Color fundus photograph; 1932x1932px; 45° field of view
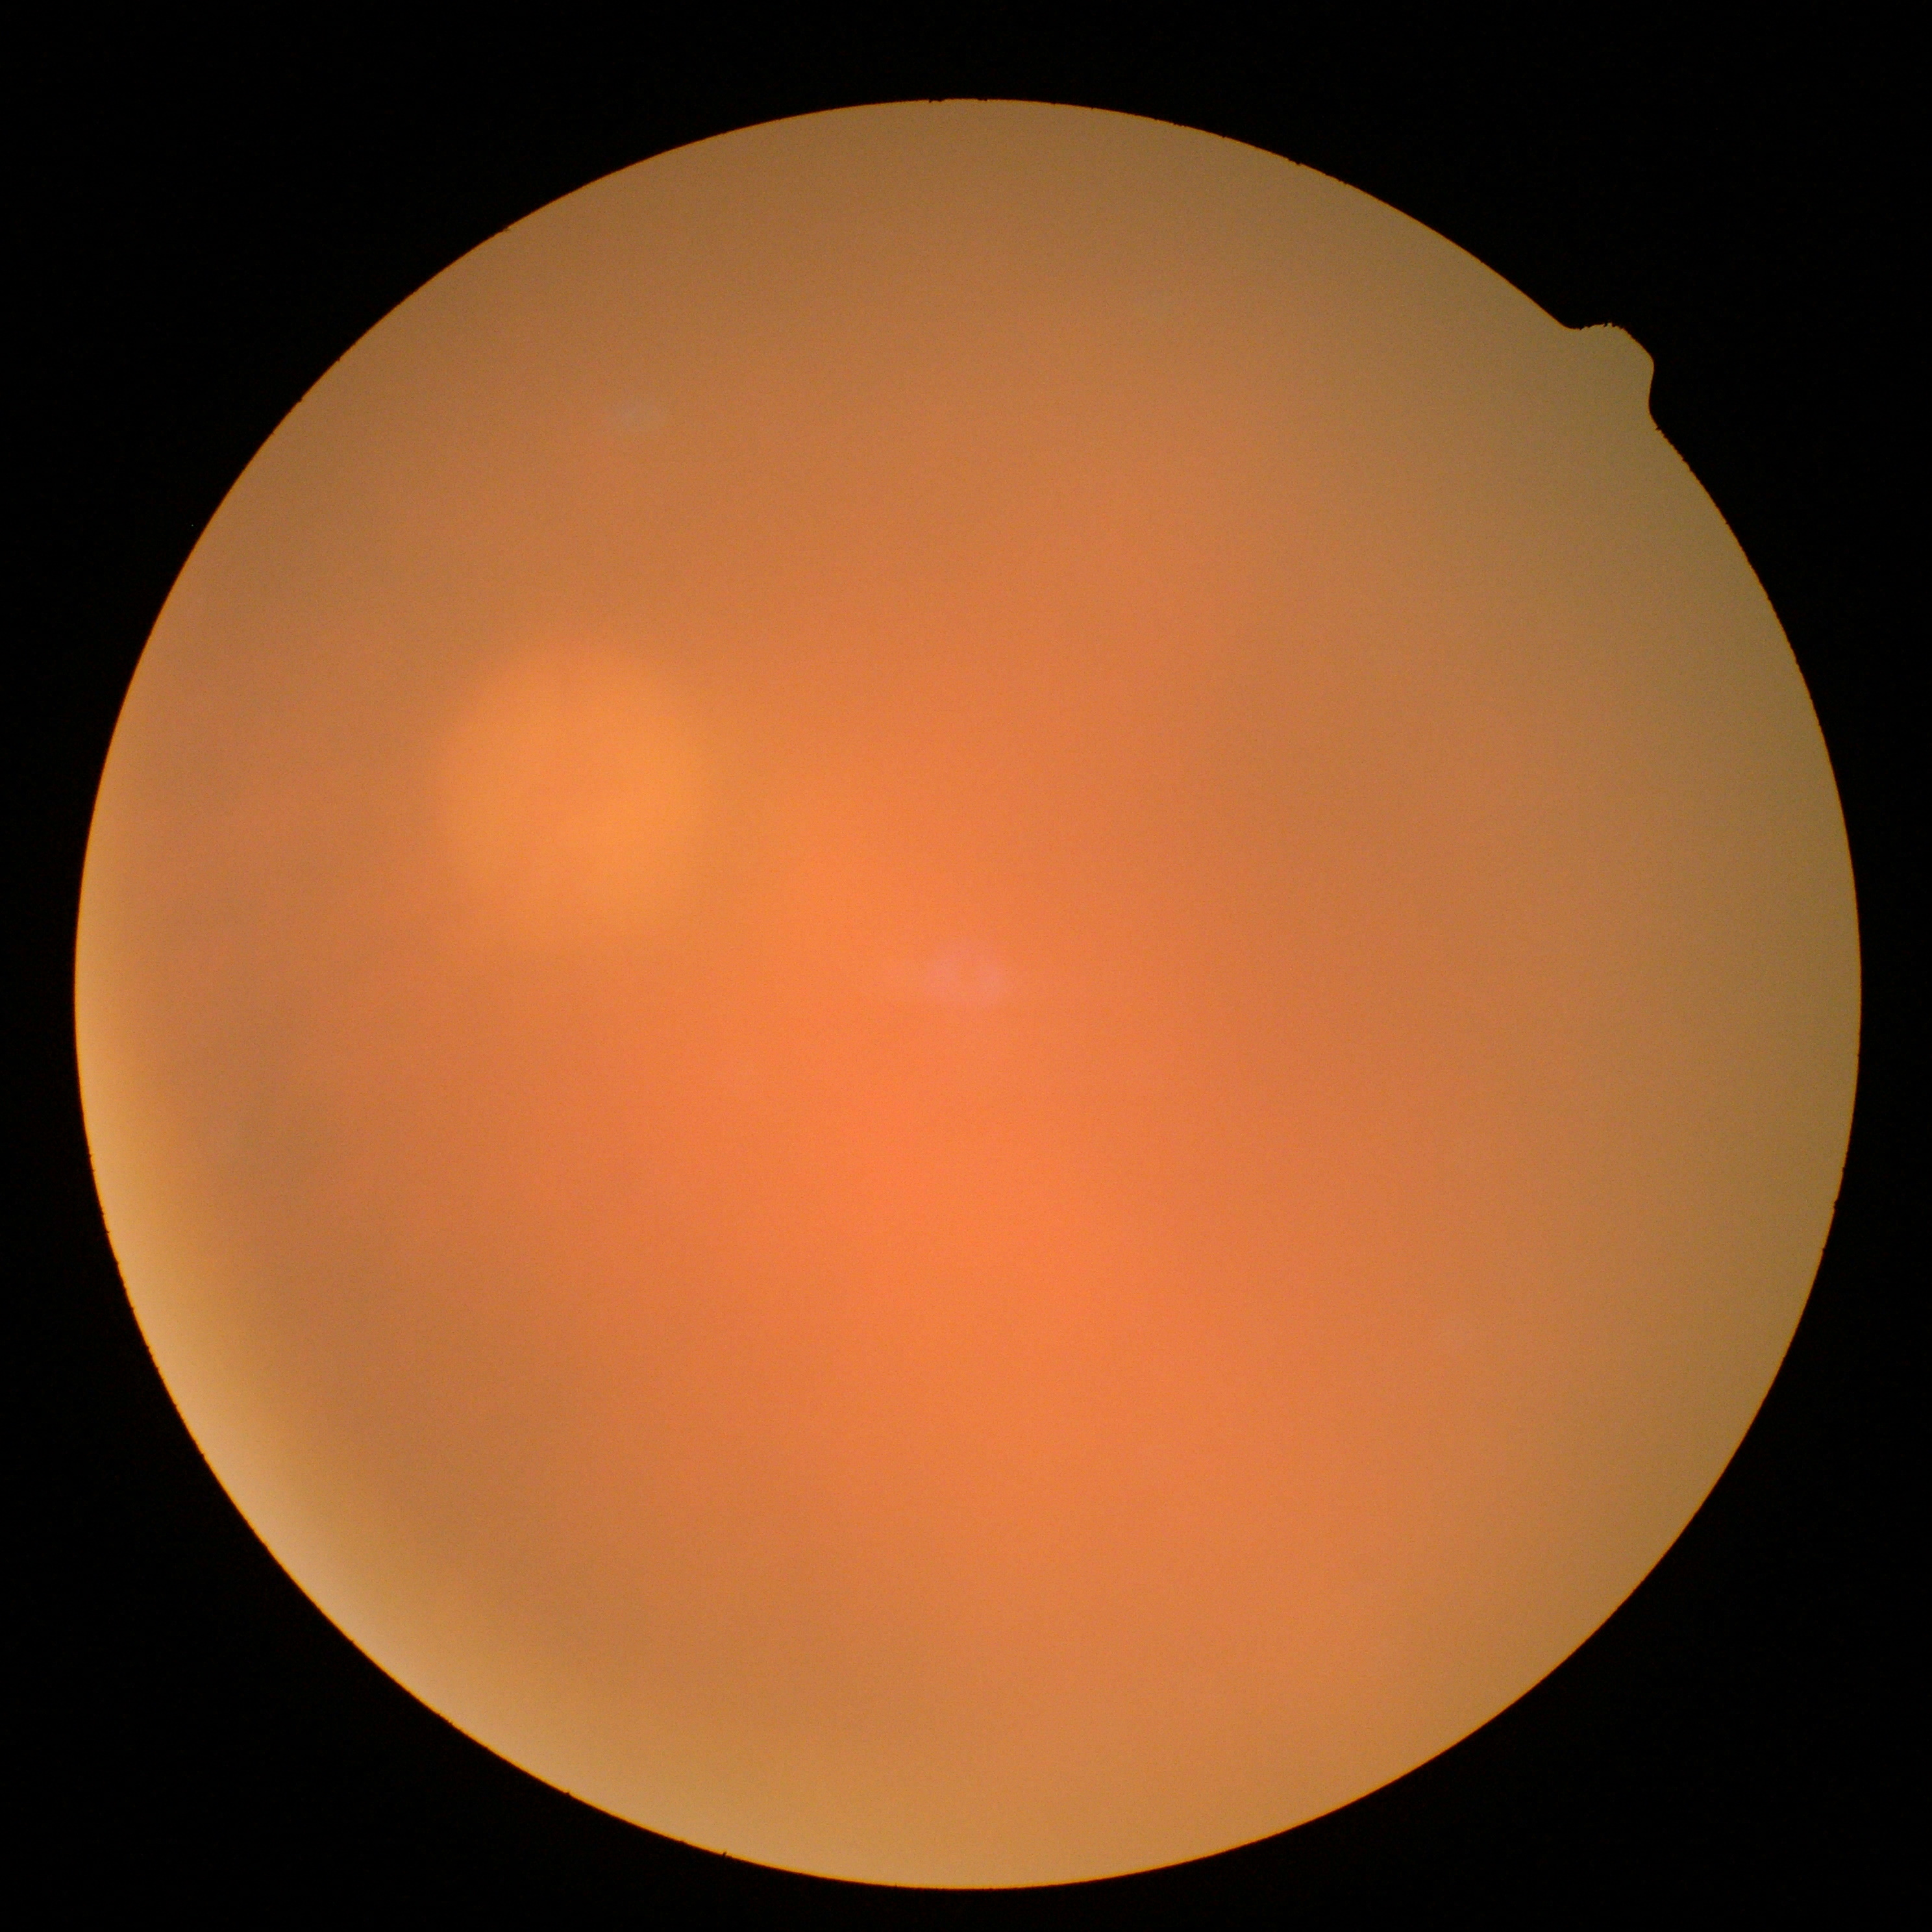 Quality too poor to assess for DR. DR is ungradable.